FOV: 45 degrees · posterior pole color fundus photograph · diabetic retinopathy graded by the modified Davis classification · NIDEK AFC-230 fundus camera:
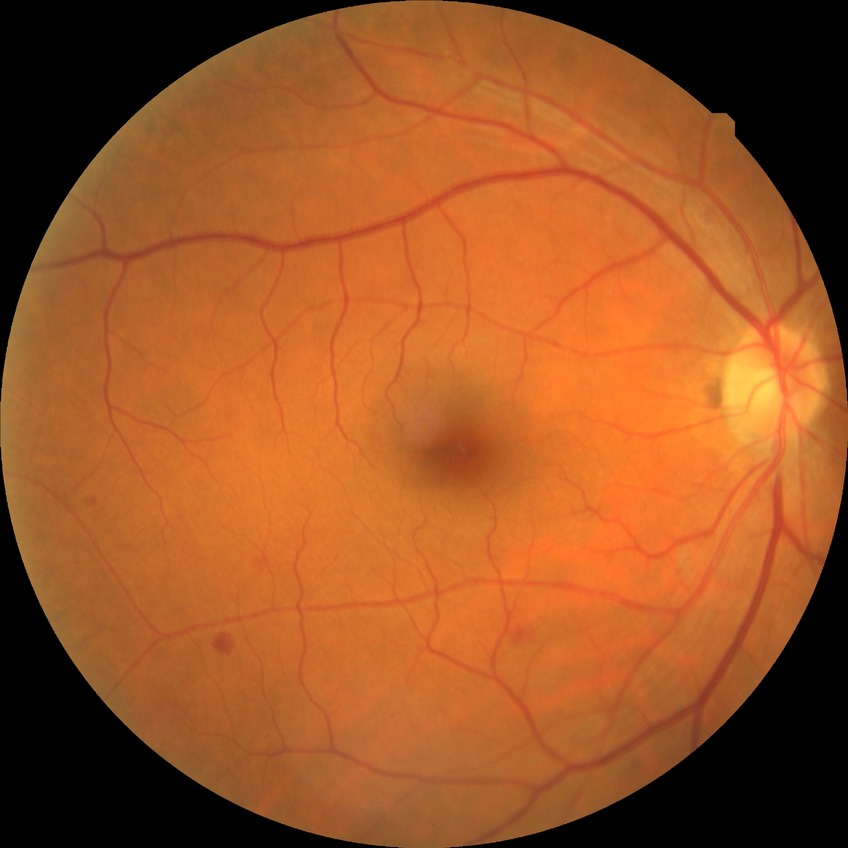

Davis stage is SDR.